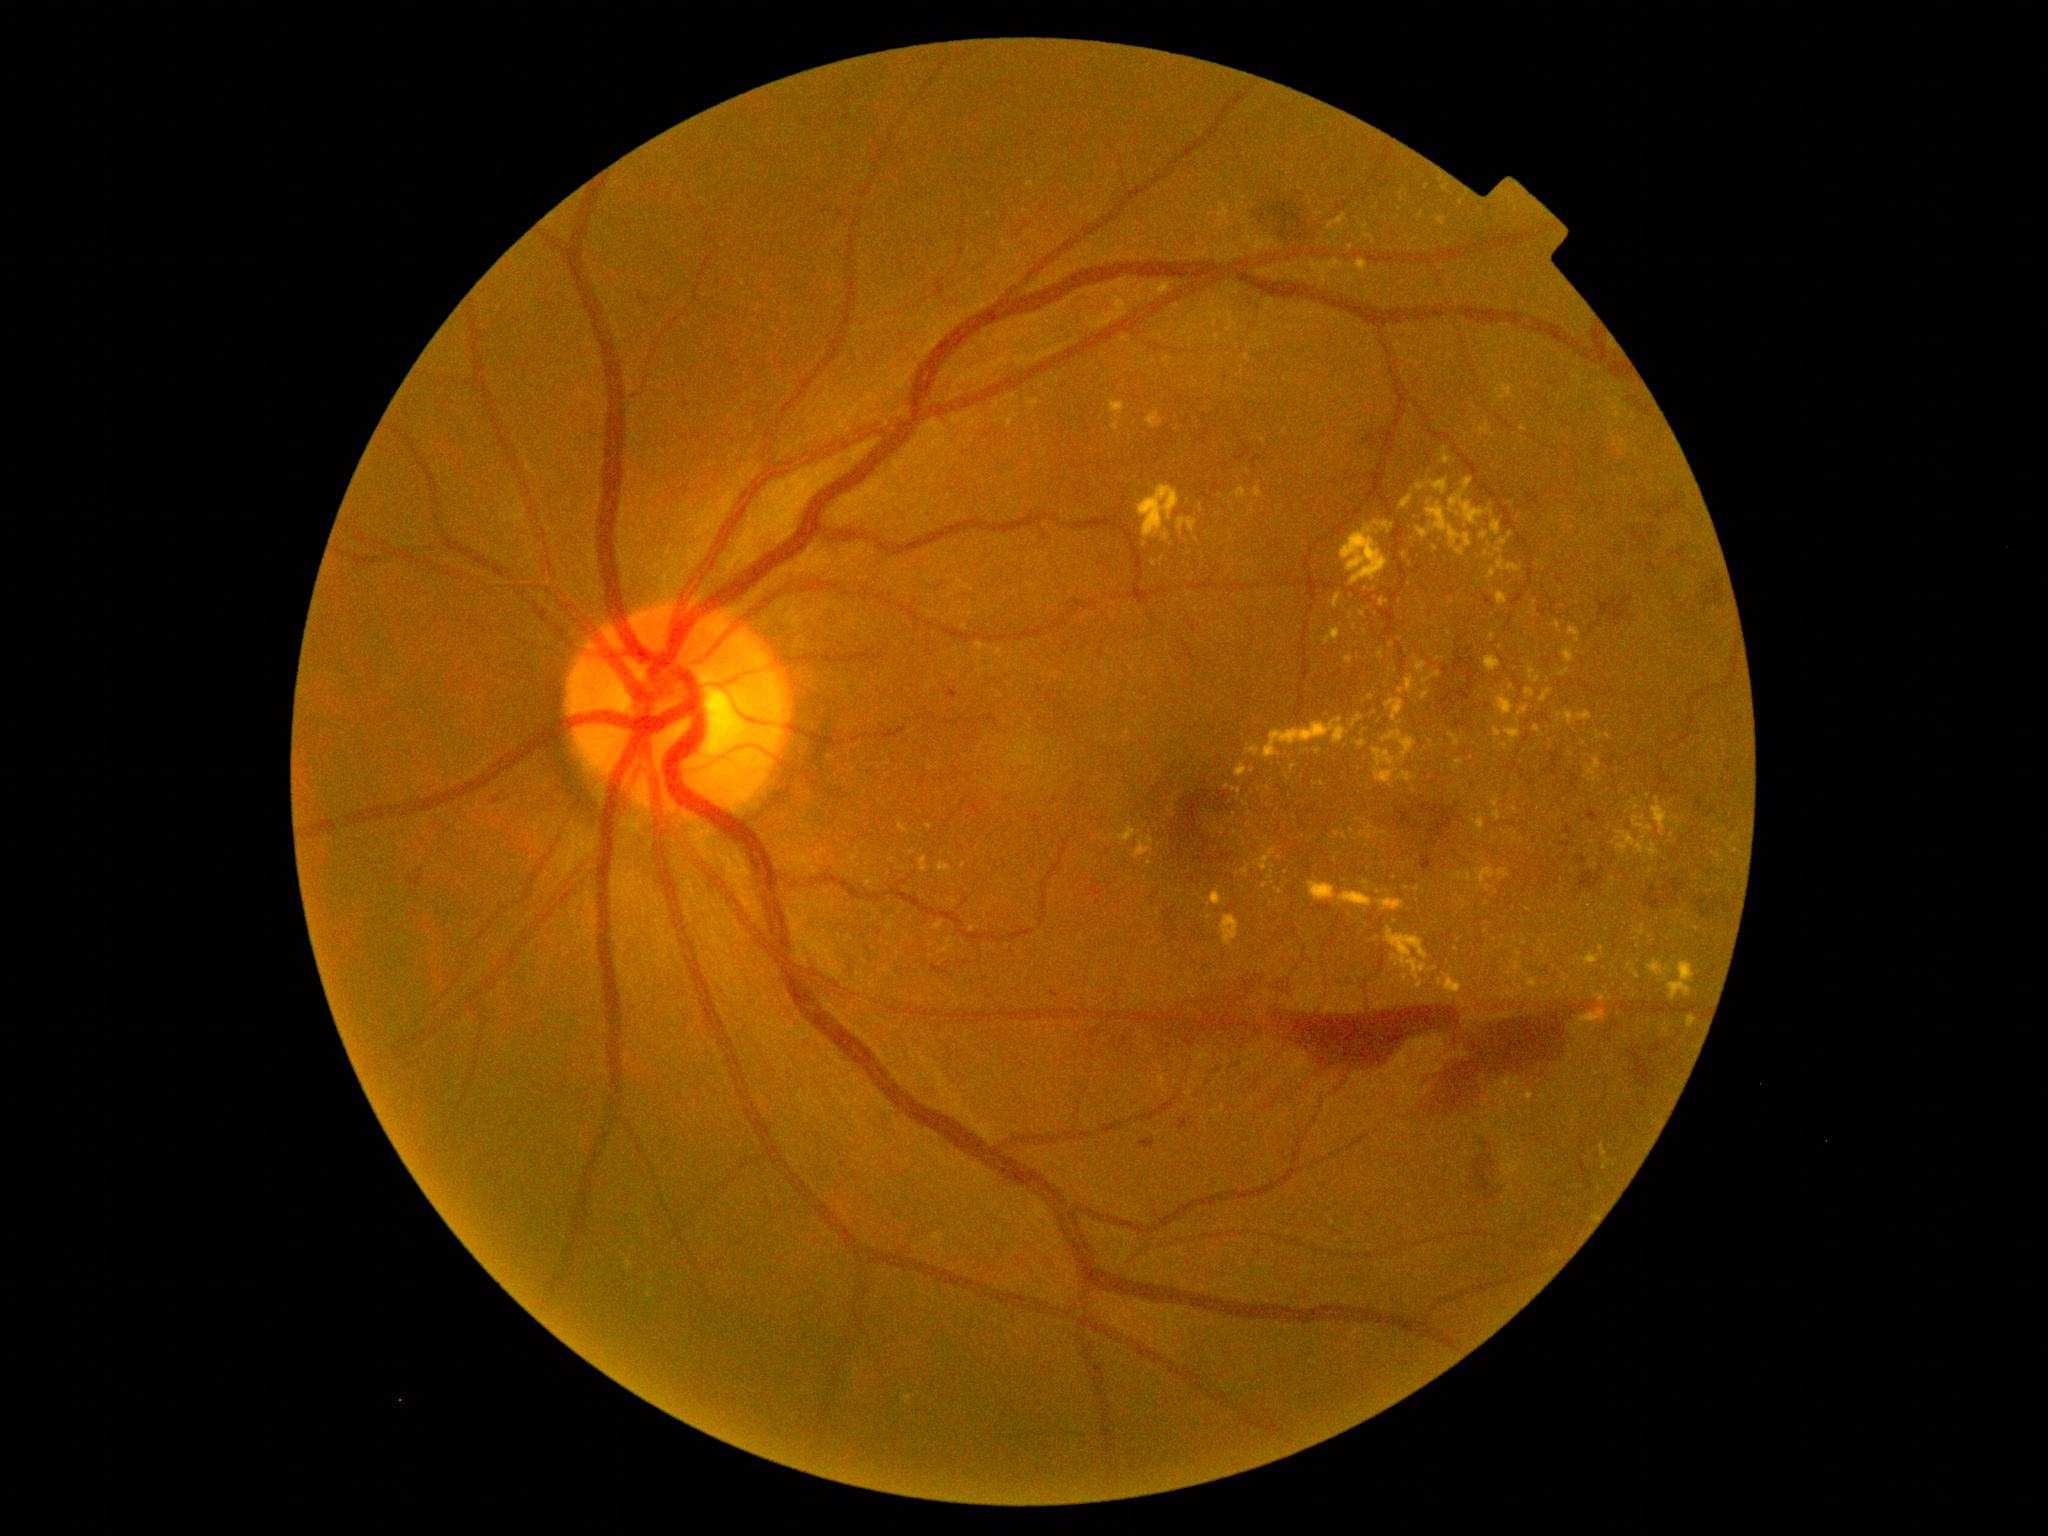 Diabetic retinopathy (DR): proliferative diabetic retinopathy (grade 4). Hard exudates (EXs) (partial list) at BBox(1565, 649, 1575, 663) | BBox(1580, 1011, 1605, 1022) | BBox(1444, 974, 1463, 994) | BBox(1669, 962, 1695, 1001) | BBox(1540, 690, 1553, 703) | BBox(1444, 457, 1451, 465) | BBox(1430, 967, 1438, 972) | BBox(1506, 992, 1516, 999) | BBox(920, 856, 927, 872) | BBox(1600, 1146, 1608, 1157). Additional small EXs near <point>1505, 996</point> | <point>1503, 397</point> | <point>1404, 555</point> | <point>1239, 873</point> | <point>1401, 691</point> | <point>1736, 851</point> | <point>1337, 834</point> | <point>1154, 564</point> | <point>1560, 715</point>.